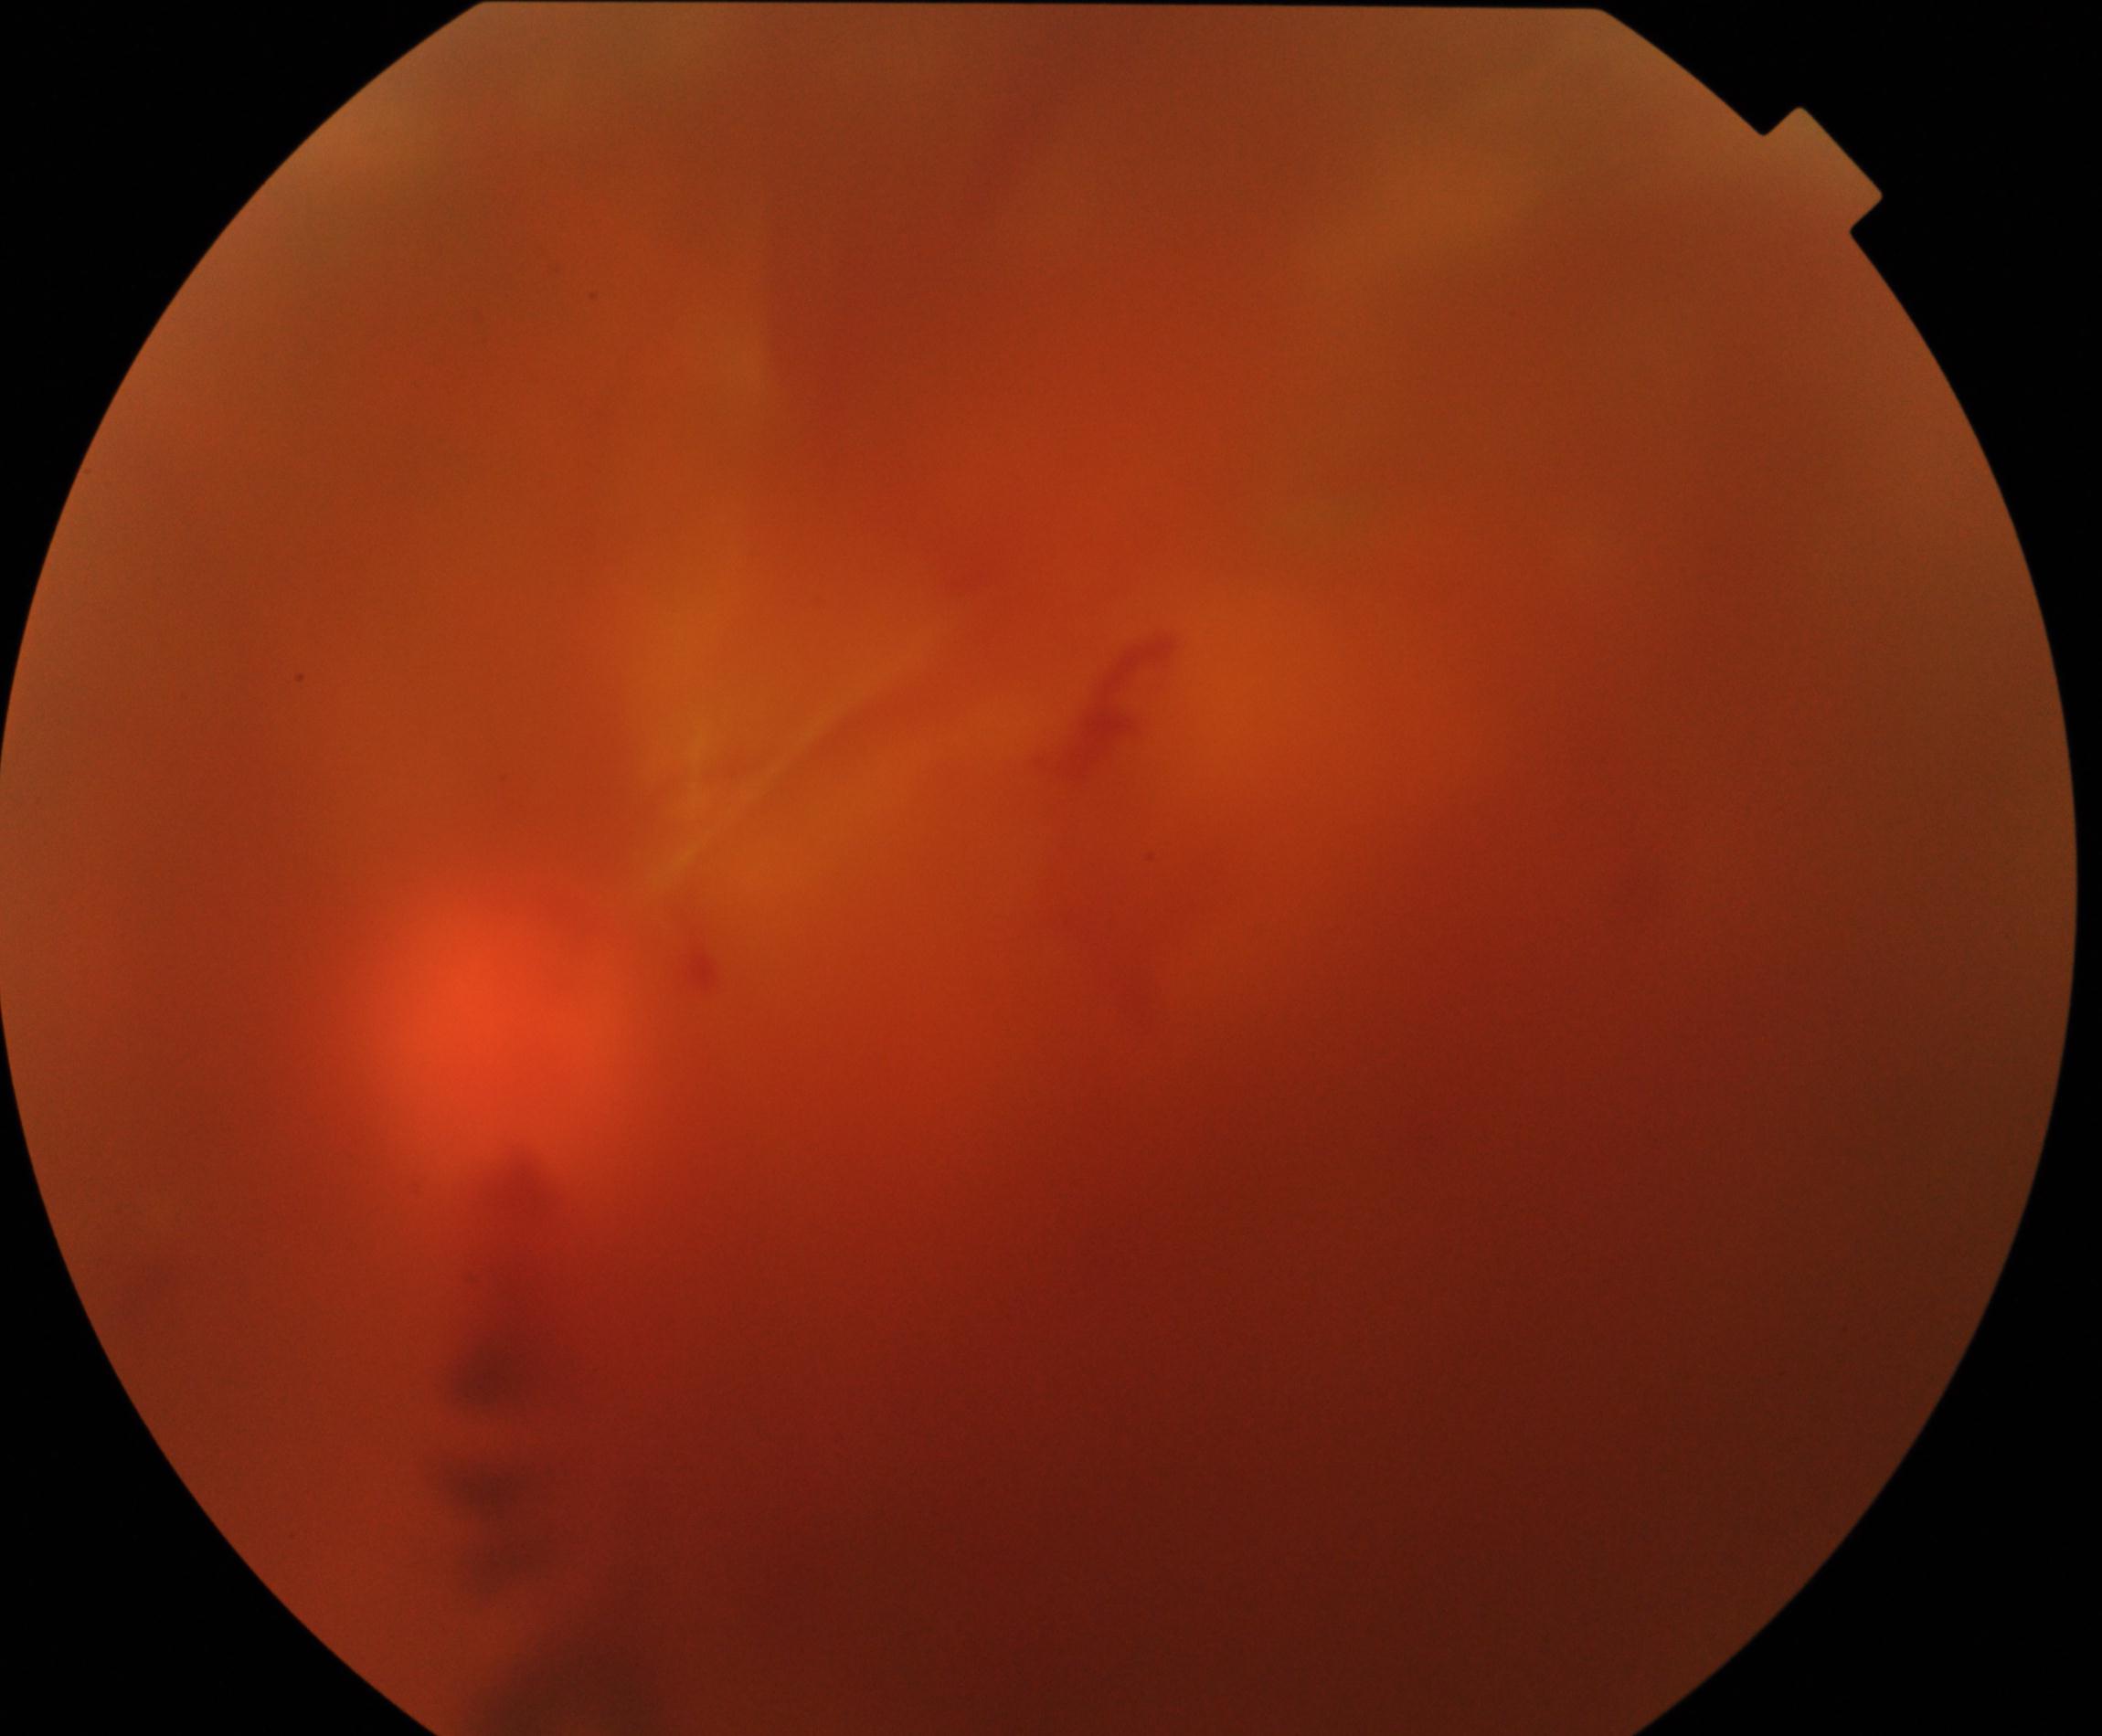 Image quality is poor; more than half the field is obscured. Features suspicious for proliferative diabetic retinopathy.